30-degree field of view · autorefraction: sphere +3.75 D, cylinder -1 D, axis 95° · axial length (AL): 22.91 mm · patient age: 66 years · female patient · color fundus photograph · intraocular pressure 19 mmHg by pneumatic tonometry · corneal thickness 561 µm
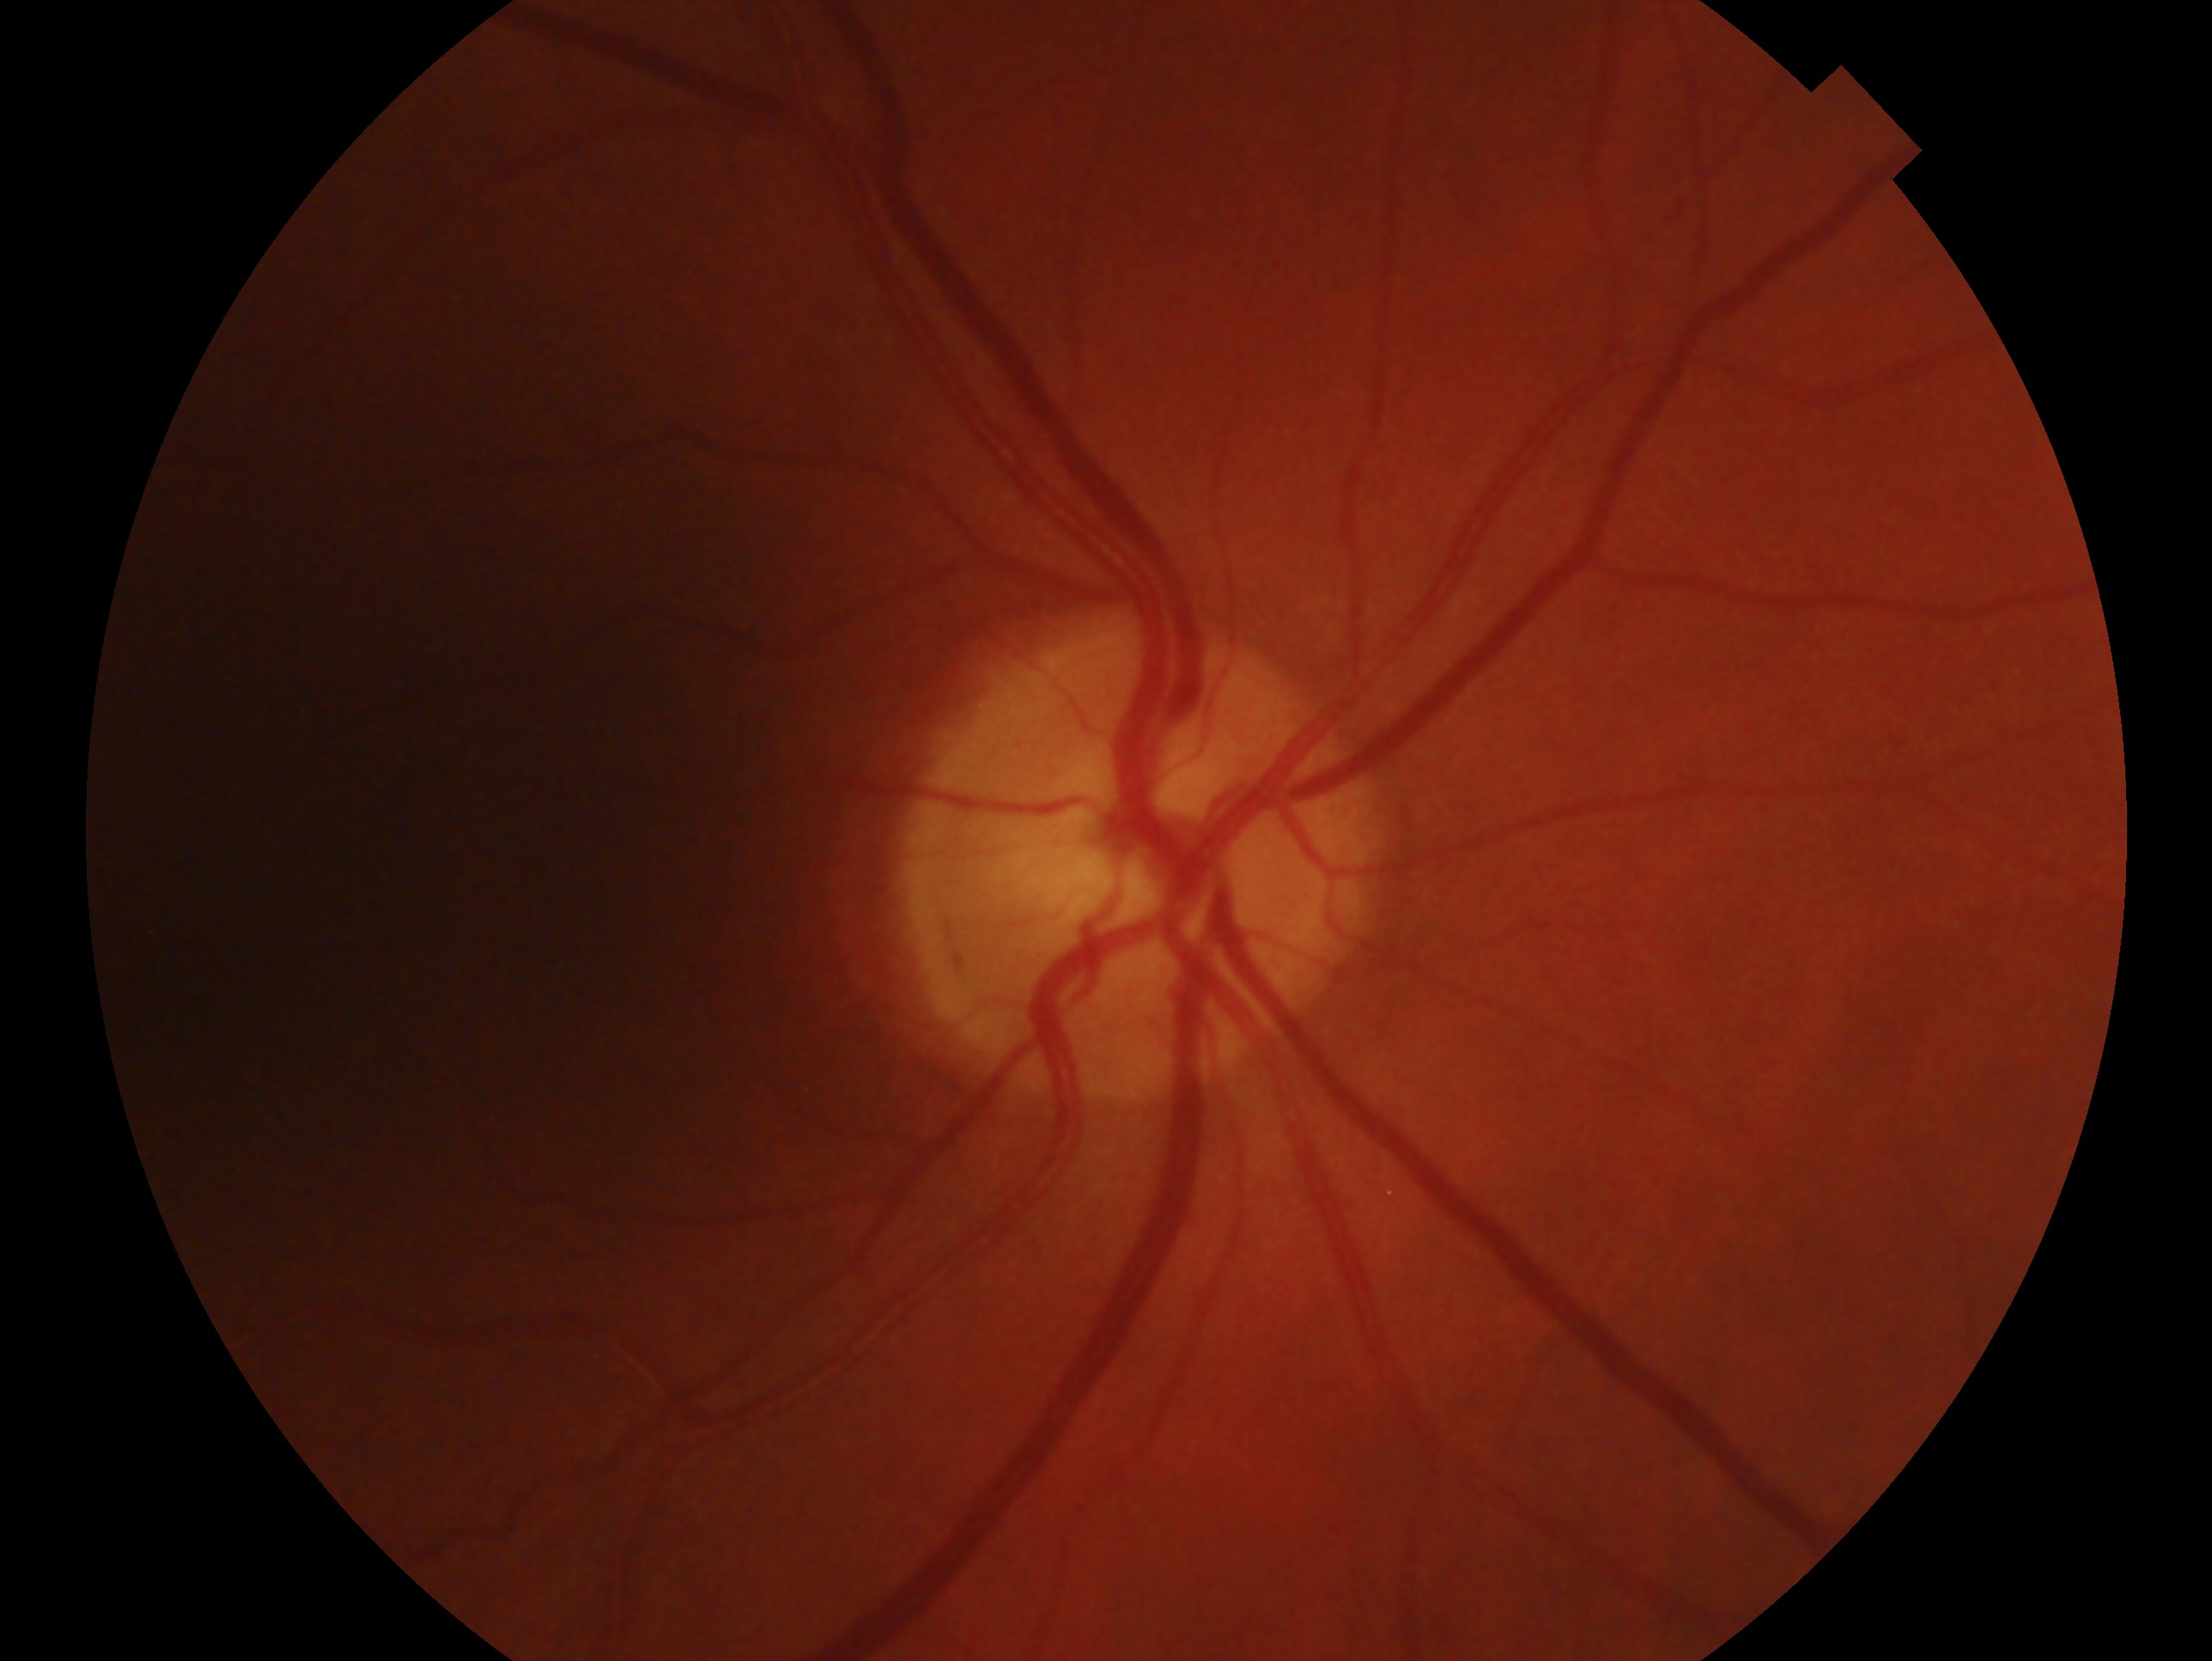

– laterality · right
– diagnosis · no glaucomatous findings — no clinical evidence of glaucoma in this eye